45-degree field of view: 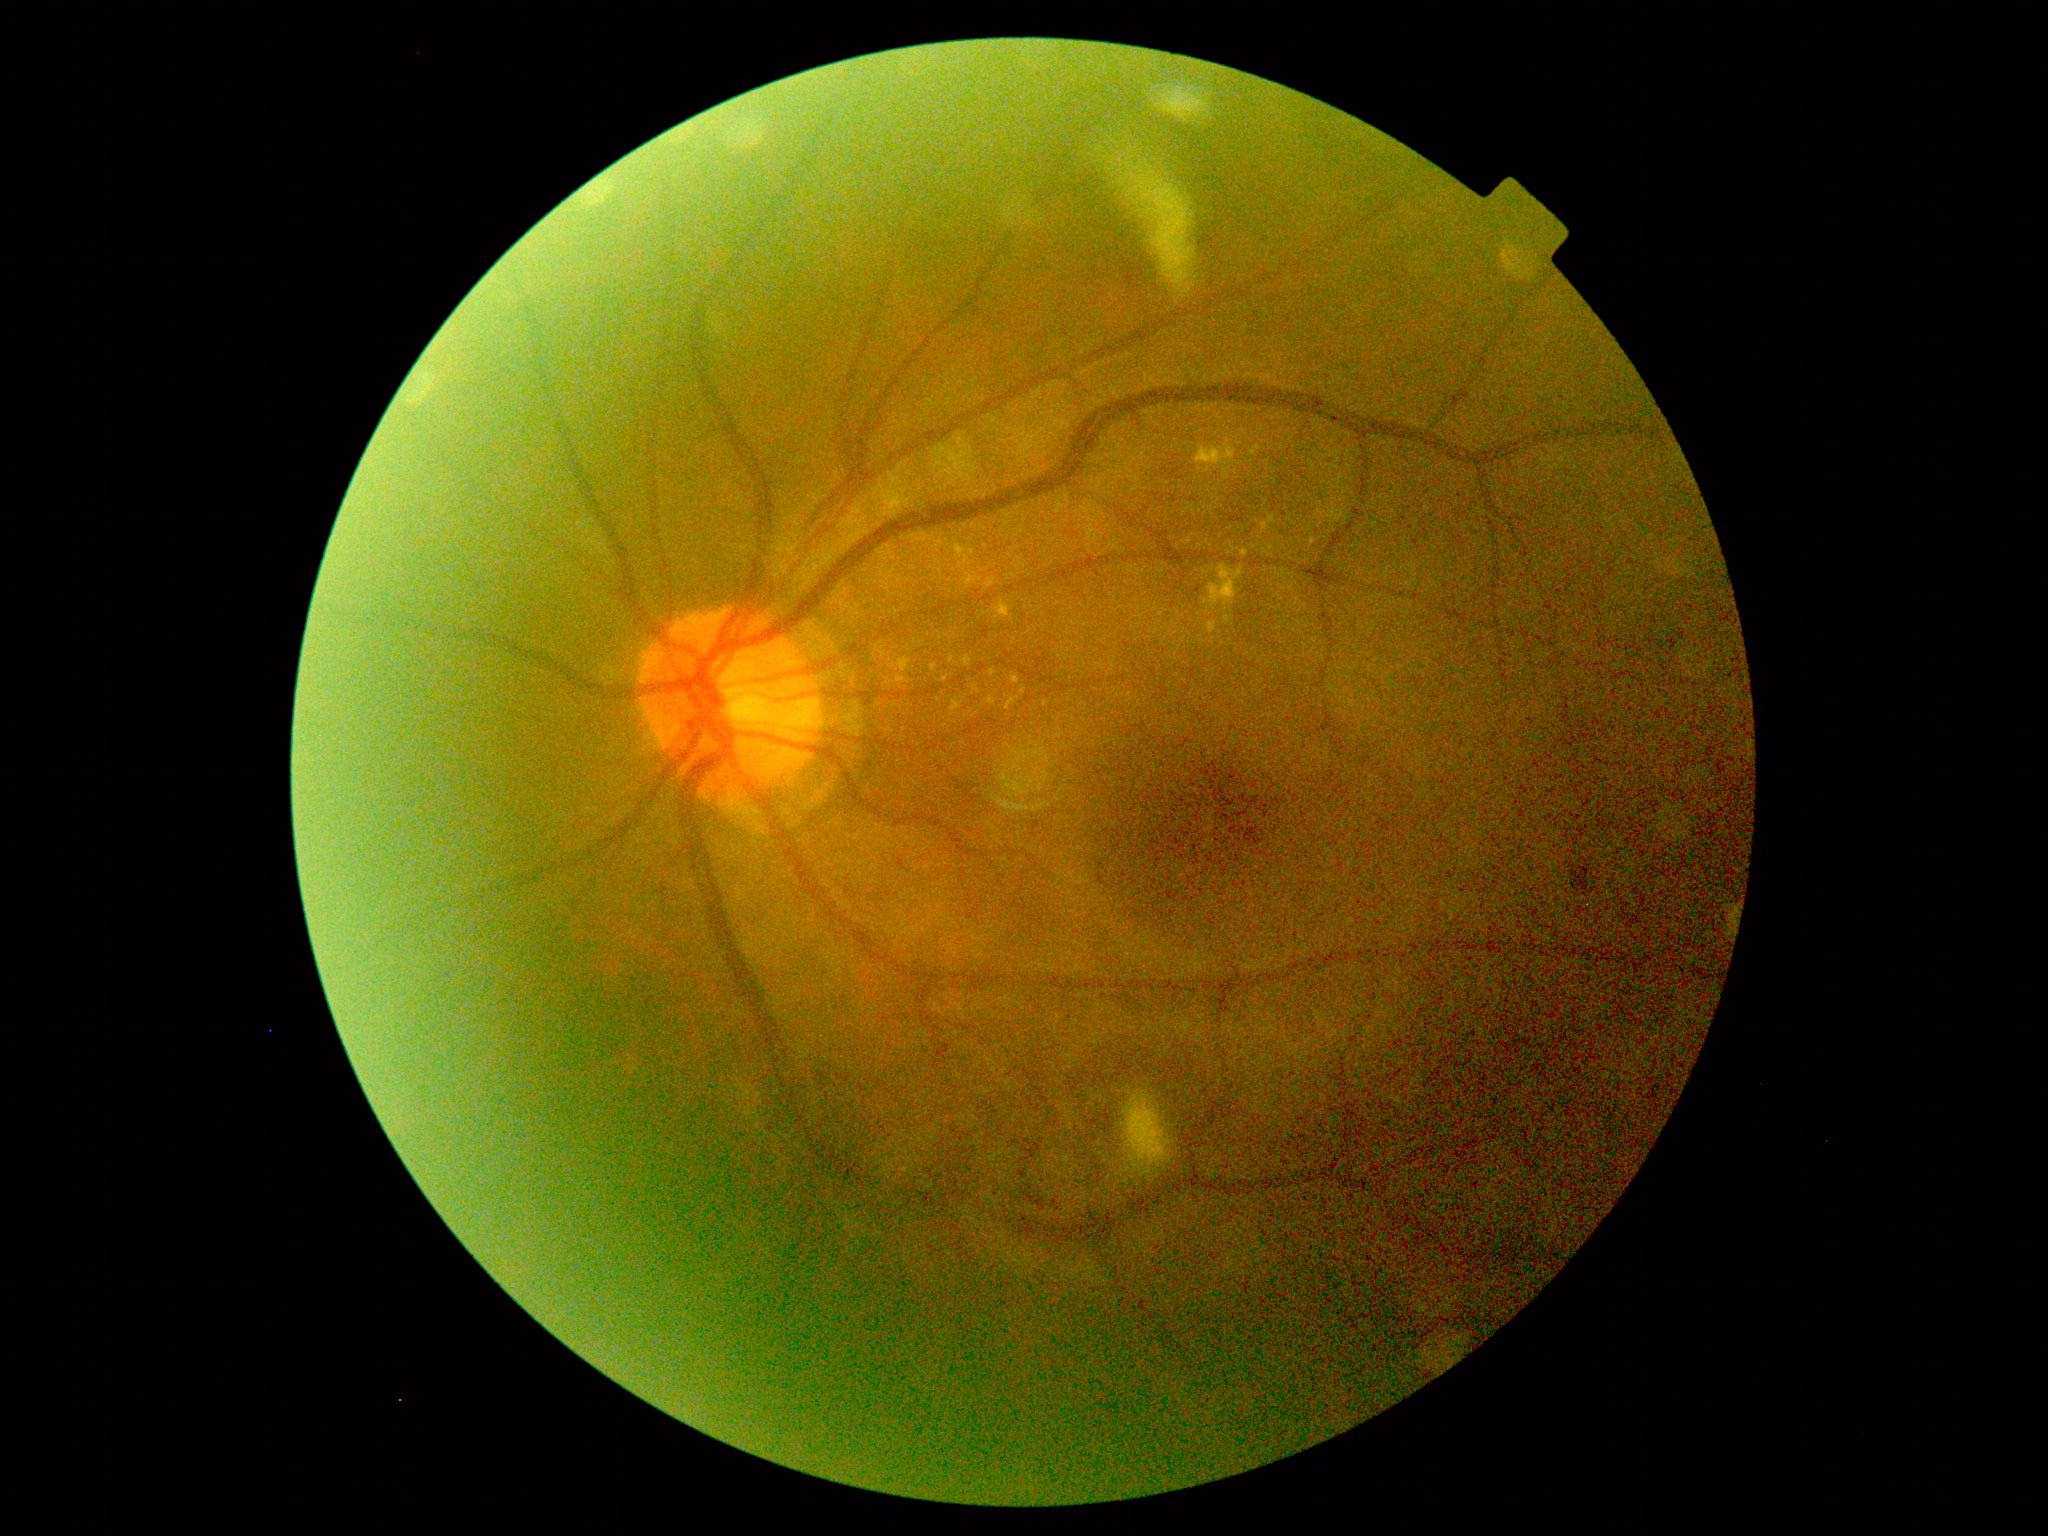
Diabetic retinopathy severity is 2.
The retinopathy is classified as non-proliferative diabetic retinopathy.